Retinal fundus photograph: 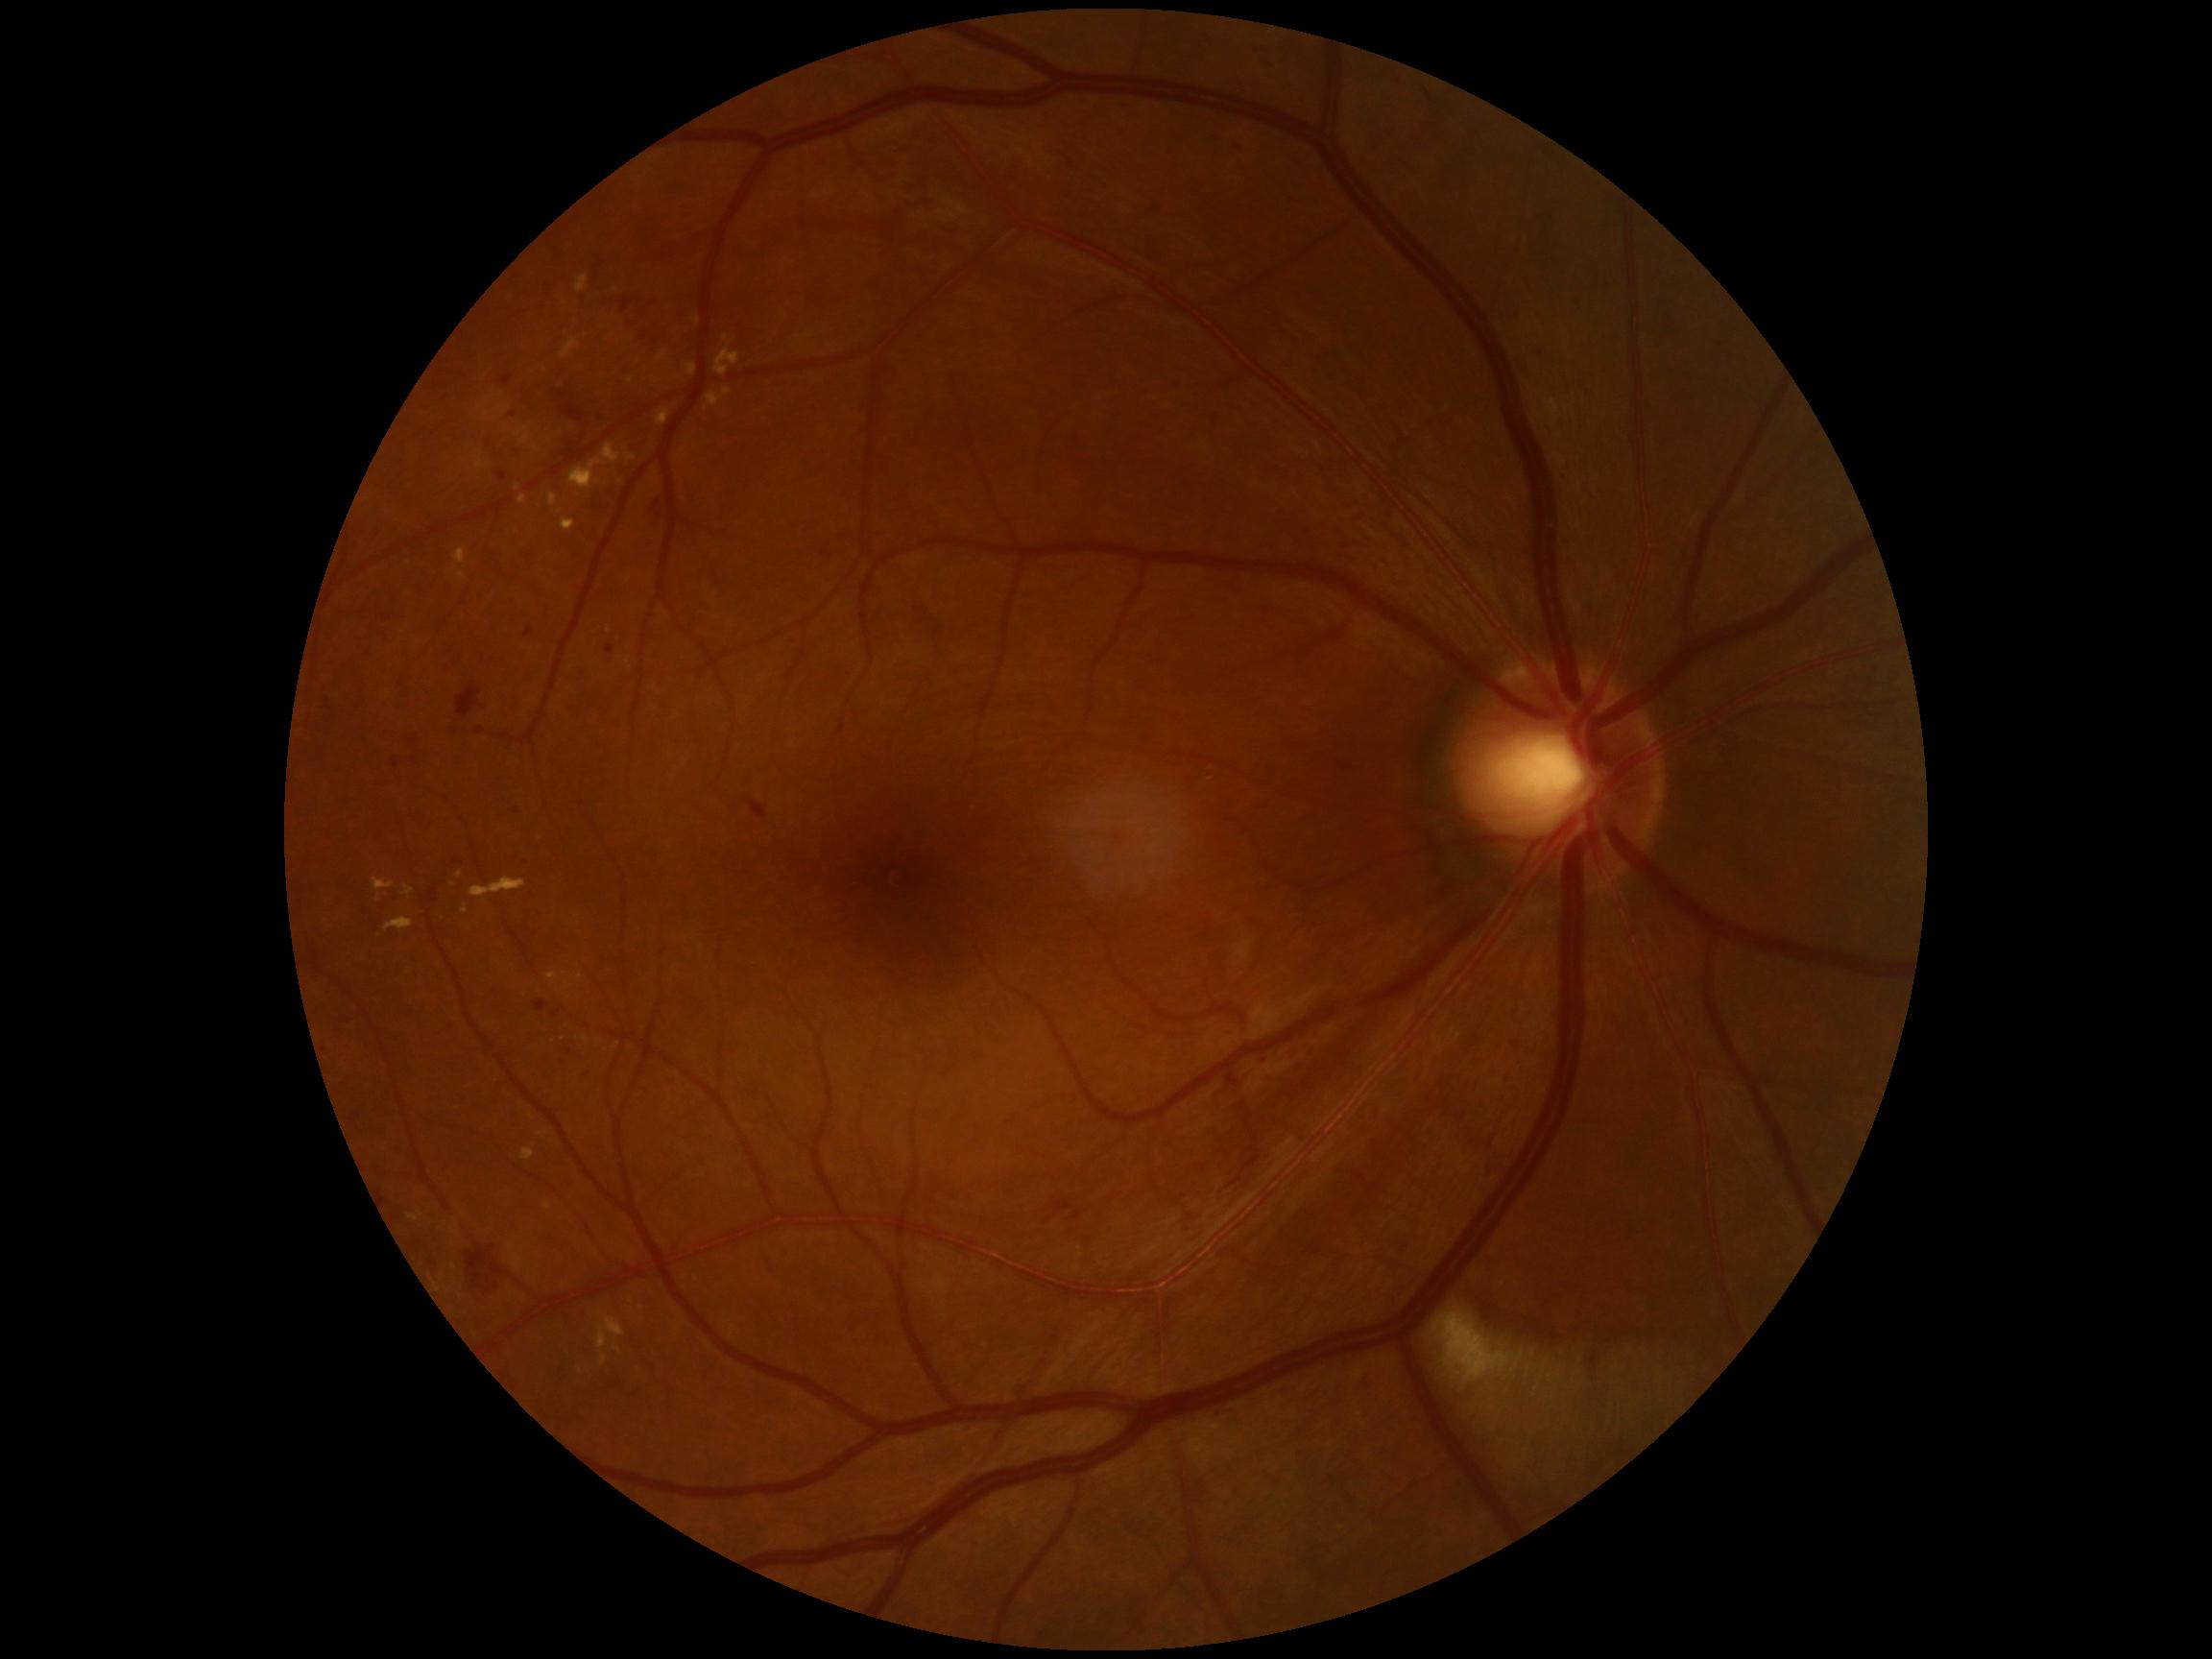 partial: true
dr_grade: 2
lesions:
  ex:
    - [left=385, top=918, right=414, bottom=932]
    - [left=519, top=495, right=528, bottom=505]
    - [left=705, top=394, right=720, bottom=412]
    - [left=627, top=455, right=637, bottom=462]
    - [left=693, top=317, right=701, bottom=324]
    - [left=476, top=453, right=484, bottom=469]
    - [left=686, top=364, right=698, bottom=376]
    - [left=724, top=389, right=732, bottom=397]
    - [left=469, top=879, right=526, bottom=899]
    - [left=454, top=548, right=467, bottom=565]
  ex_small_approx:
    - <pt>617,1046</pt>
    - <pt>540,1134</pt>
    - <pt>453,1267</pt>
    - <pt>610,631</pt>
    - <pt>618,1350</pt>
    - <pt>378,900</pt>